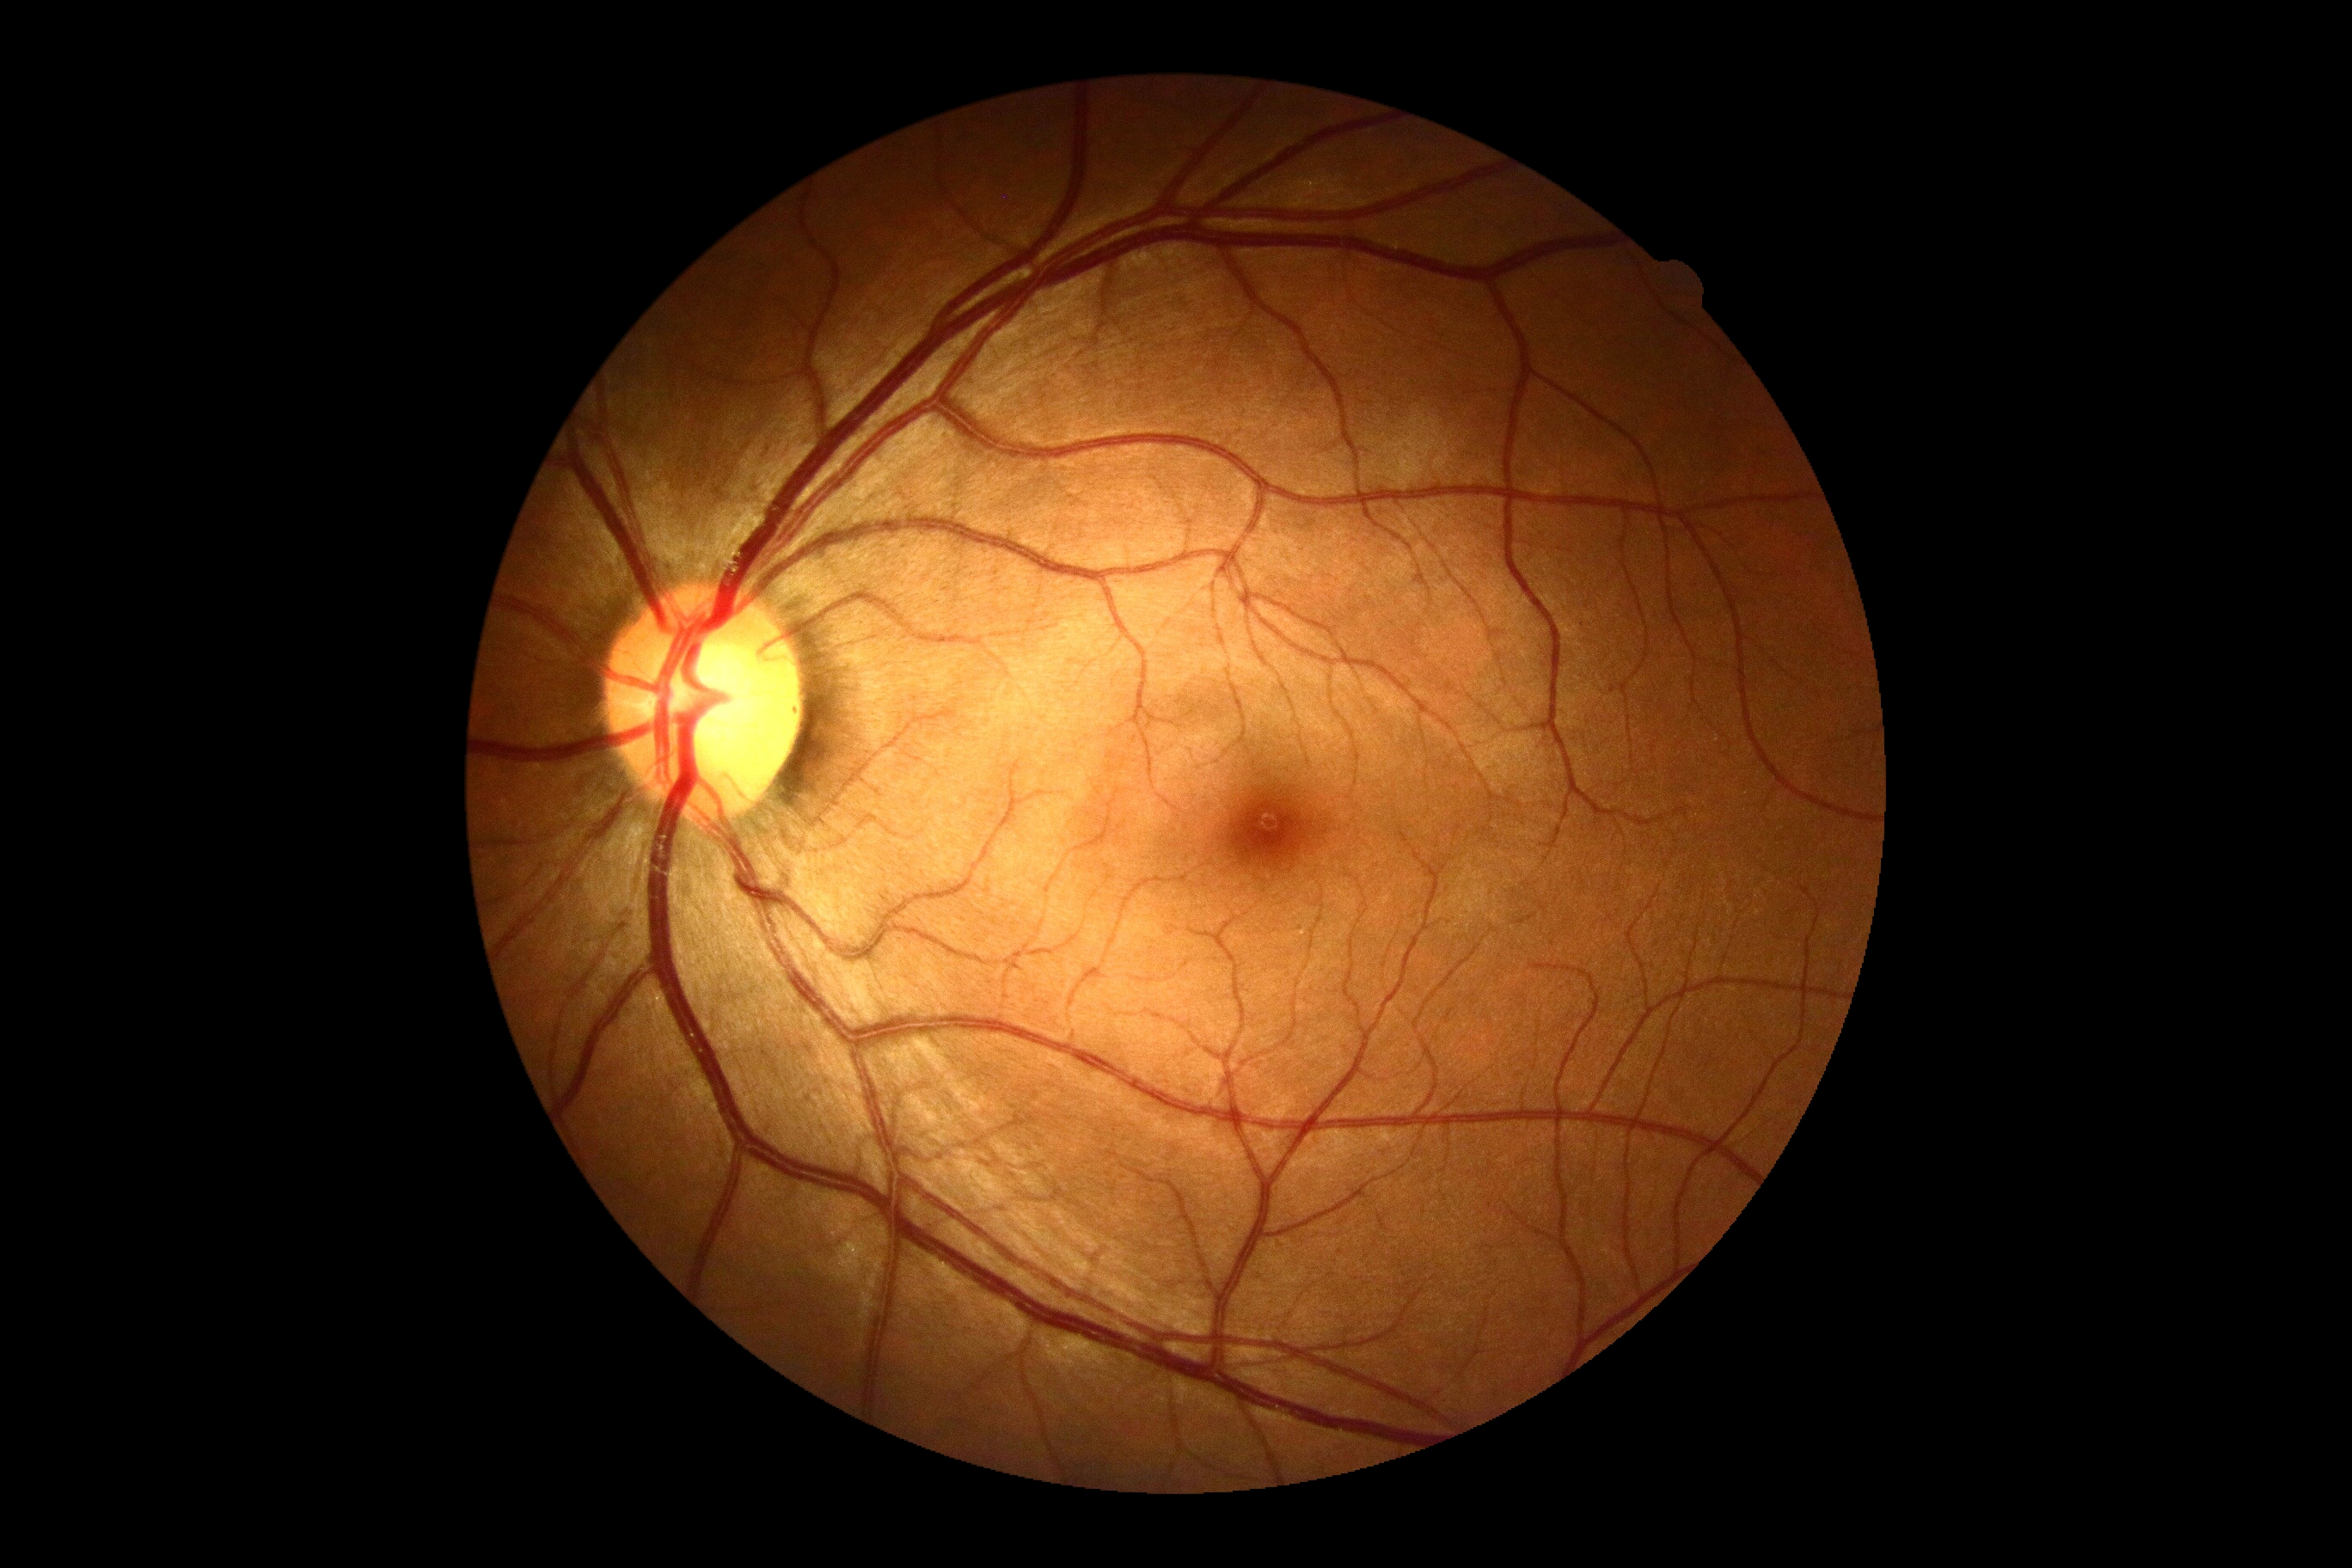

DR is 0/4.